45-degree field of view
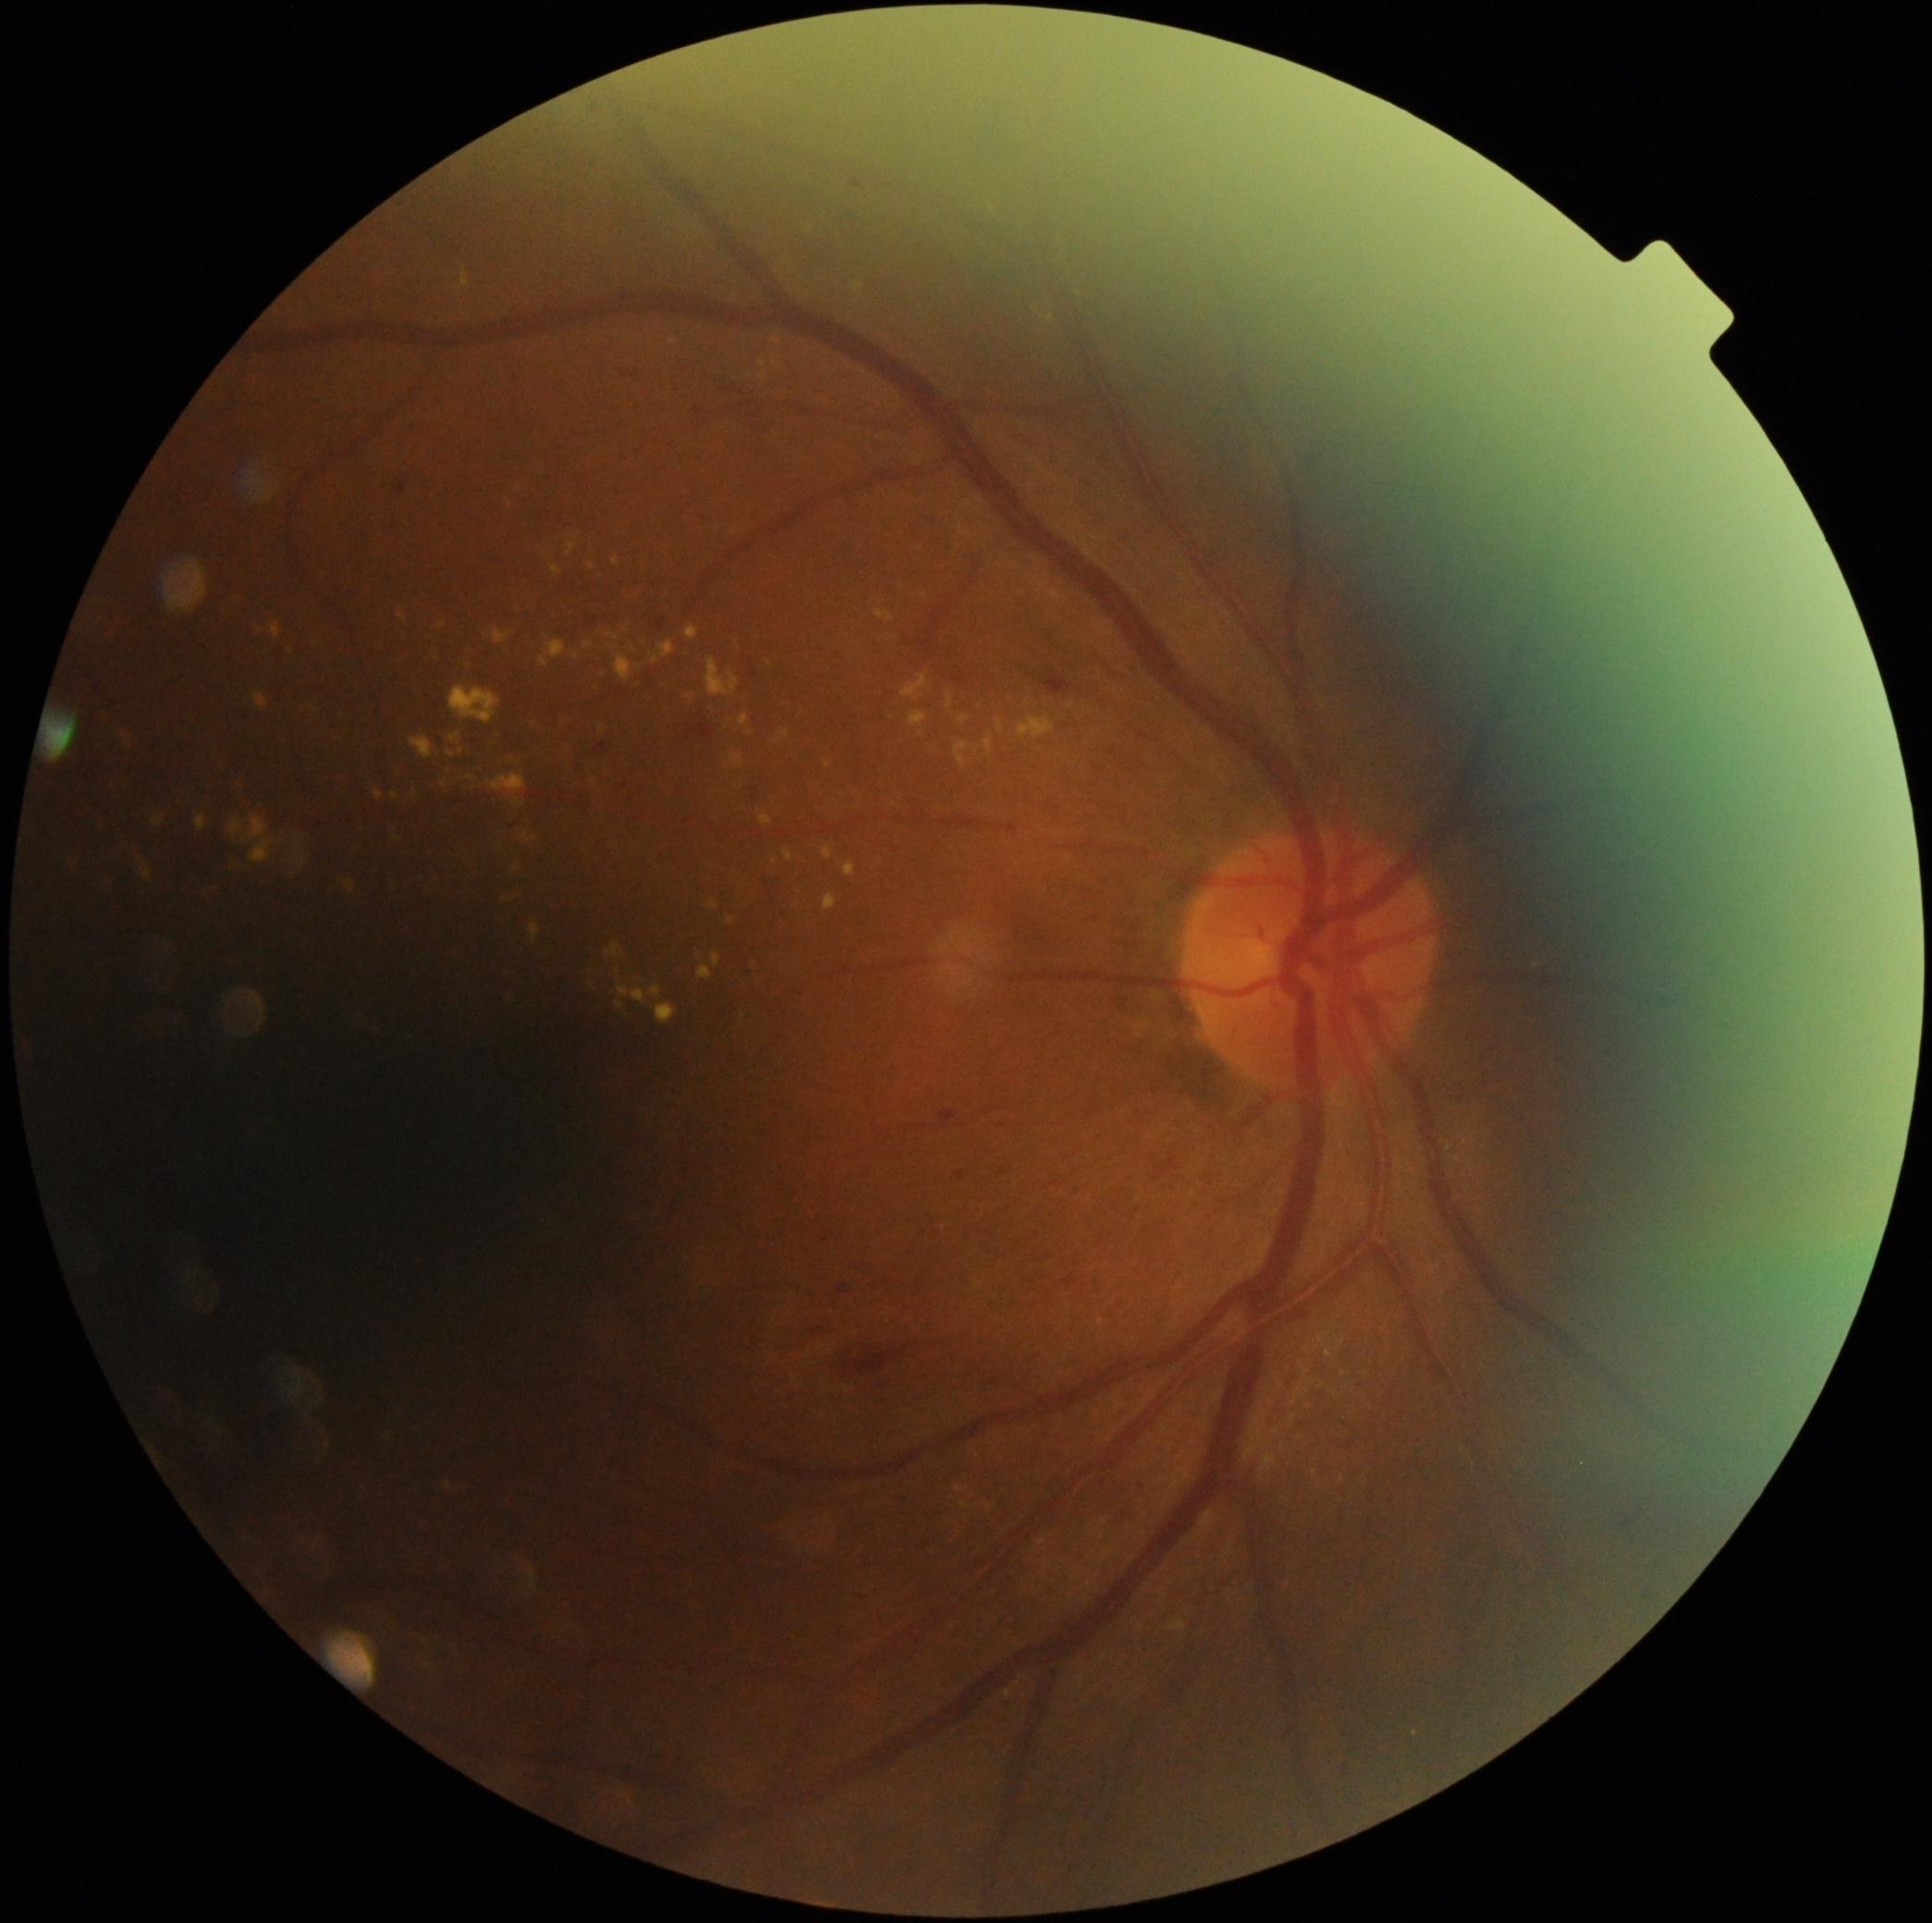
Diabetic retinopathy grade is moderate NPDR (2)
A subset of detected lesions:
microaneurysms: box(941, 1110, 956, 1123); box(656, 623, 666, 632); box(956, 1172, 965, 1182); box(752, 669, 759, 679); box(839, 1288, 847, 1295); box(397, 479, 406, 496); box(595, 742, 608, 755); box(691, 724, 713, 737); box(841, 212, 855, 217)
hard exudates (partial): box(223, 812, 309, 883); box(651, 656, 658, 666); box(96, 885, 115, 896); box(713, 953, 722, 968); box(154, 819, 165, 827); box(760, 361, 767, 369); box(339, 883, 356, 894); box(1004, 1689, 1011, 1699); box(142, 867, 153, 881); box(255, 692, 270, 711); box(707, 901, 718, 911); box(488, 774, 526, 793); box(606, 942, 625, 960); box(393, 793, 398, 801); box(272, 625, 281, 638)
Small hard exudates near 993/212; 730/921; 415/794; 634/650; 778/342
hemorrhages: box(1044, 669, 1071, 695); box(834, 1339, 945, 1389); box(746, 788, 762, 804); box(812, 1330, 830, 1337); box(972, 102, 1019, 167)
soft exudates: none detected